45° field of view.
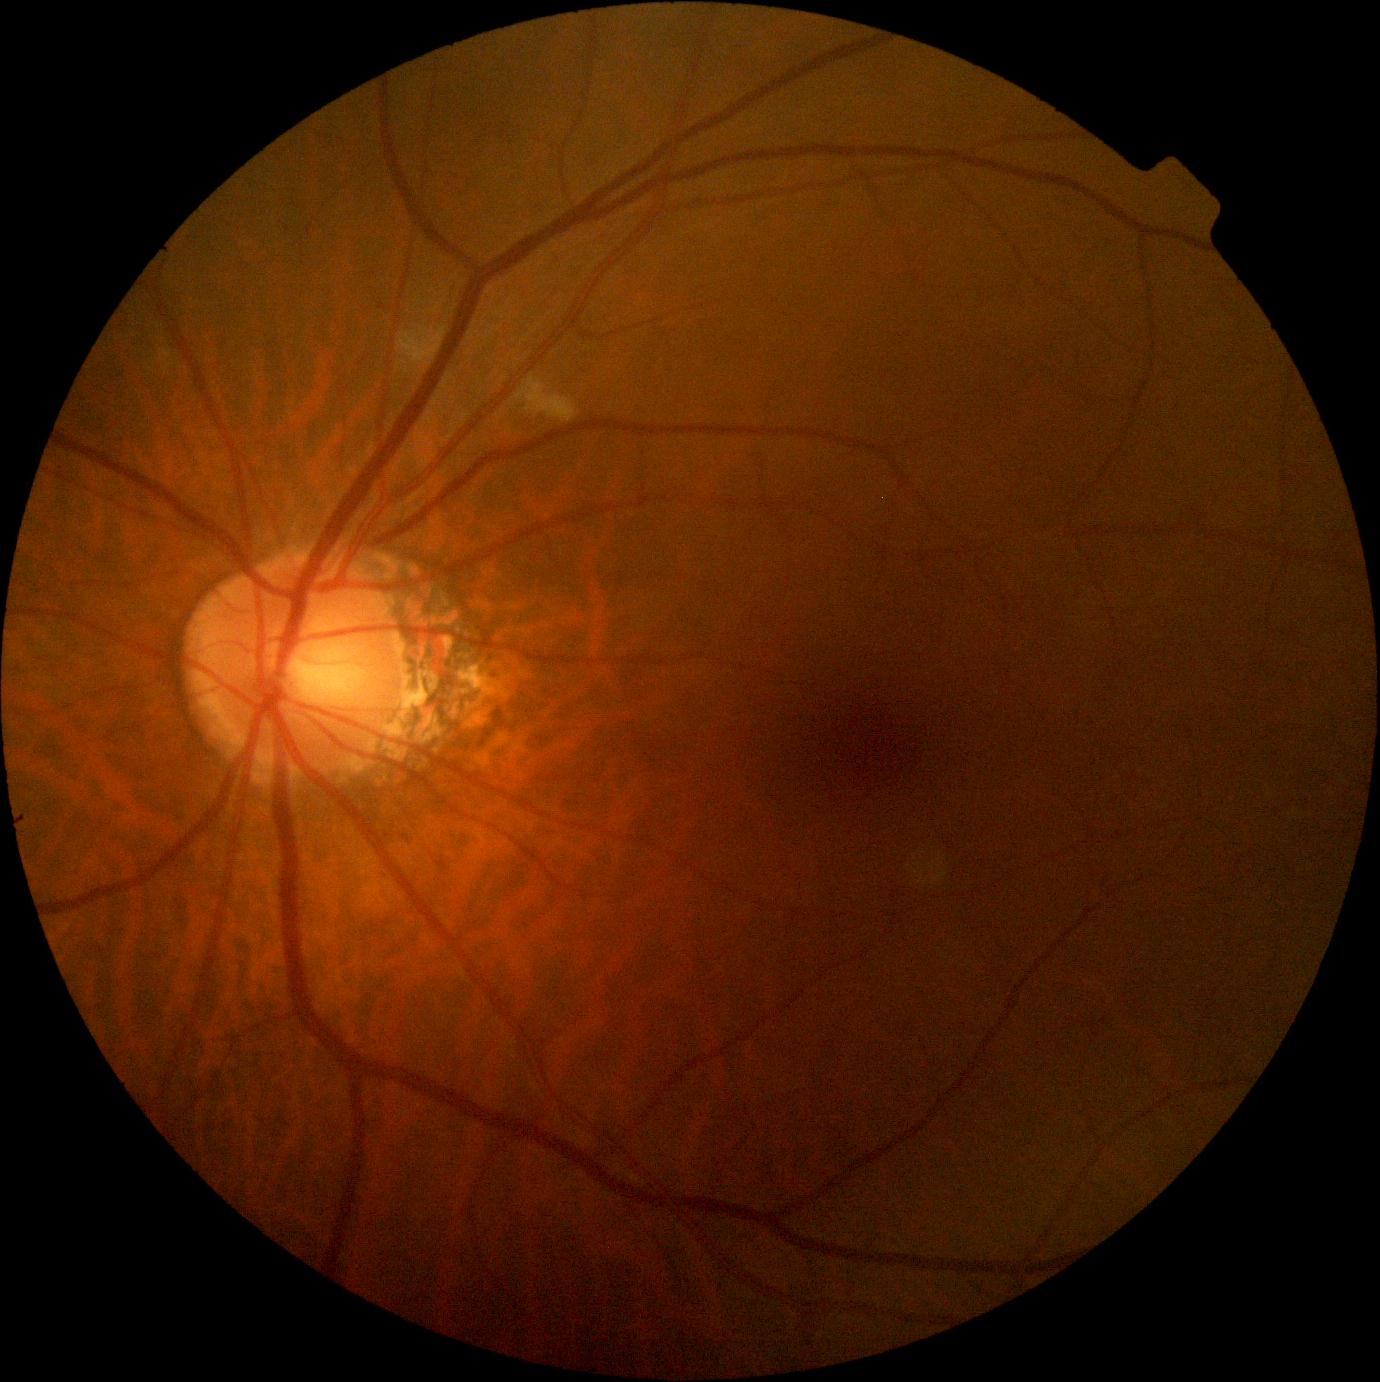 dr_category: non-proliferative diabetic retinopathy
dr_grade: grade 2